Fundus photo — 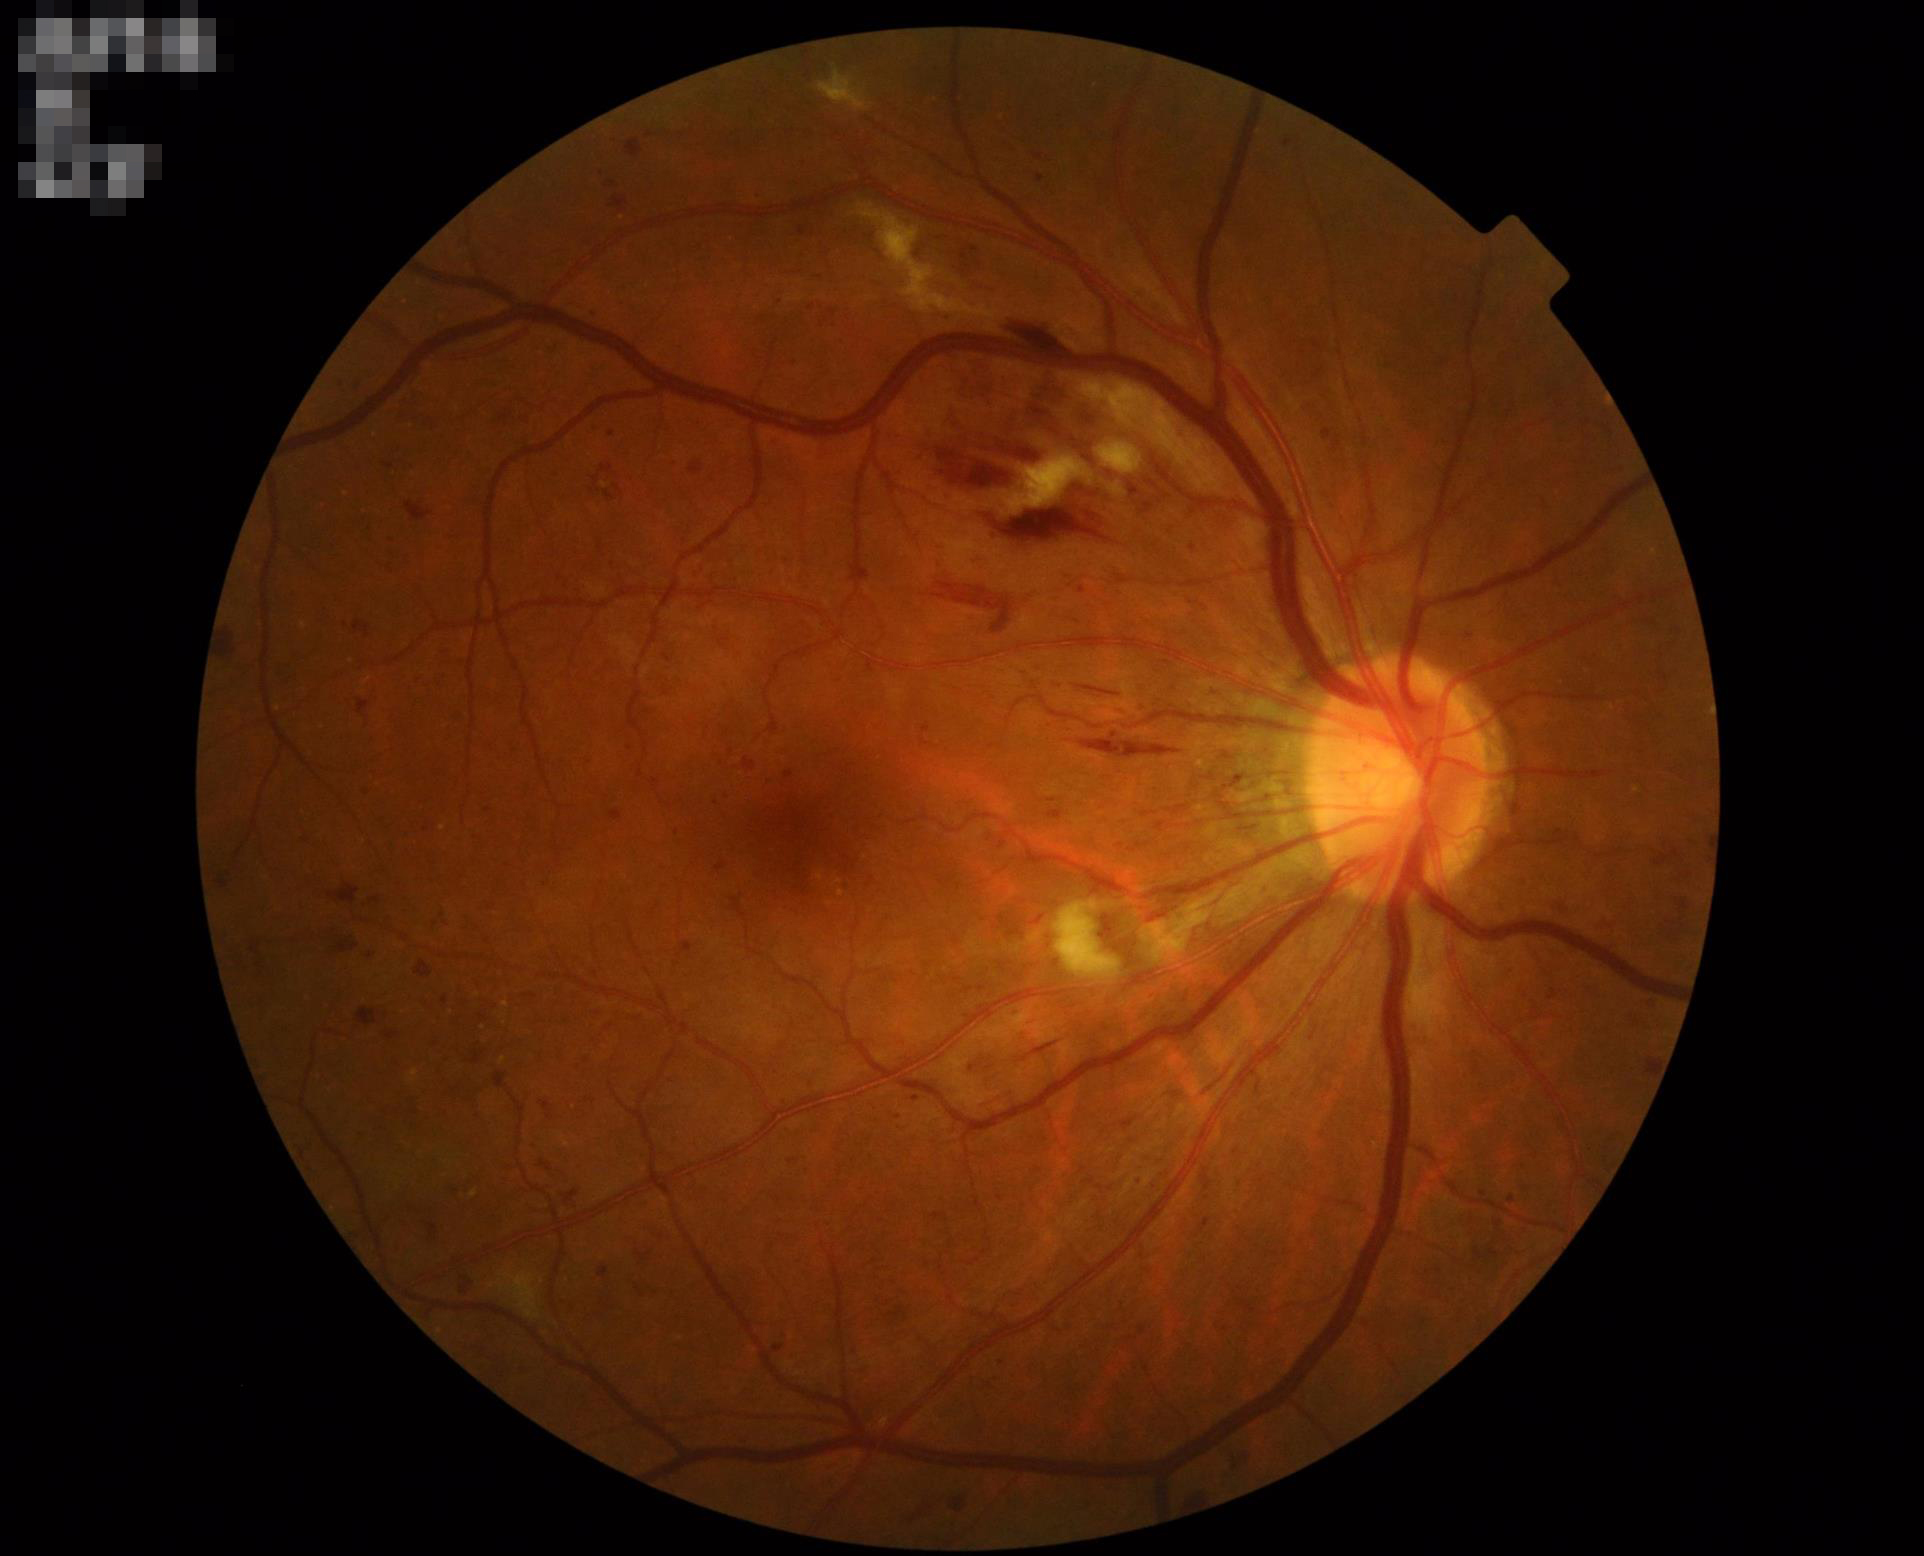 Adequate contrast for distinguishing structures.
Overall image quality is good.
No over- or under-exposure.
Optic disc, vessels, and background are in focus.